Camera: Natus RetCam Envision (130° FOV). Pediatric retinal photograph (wide-field): 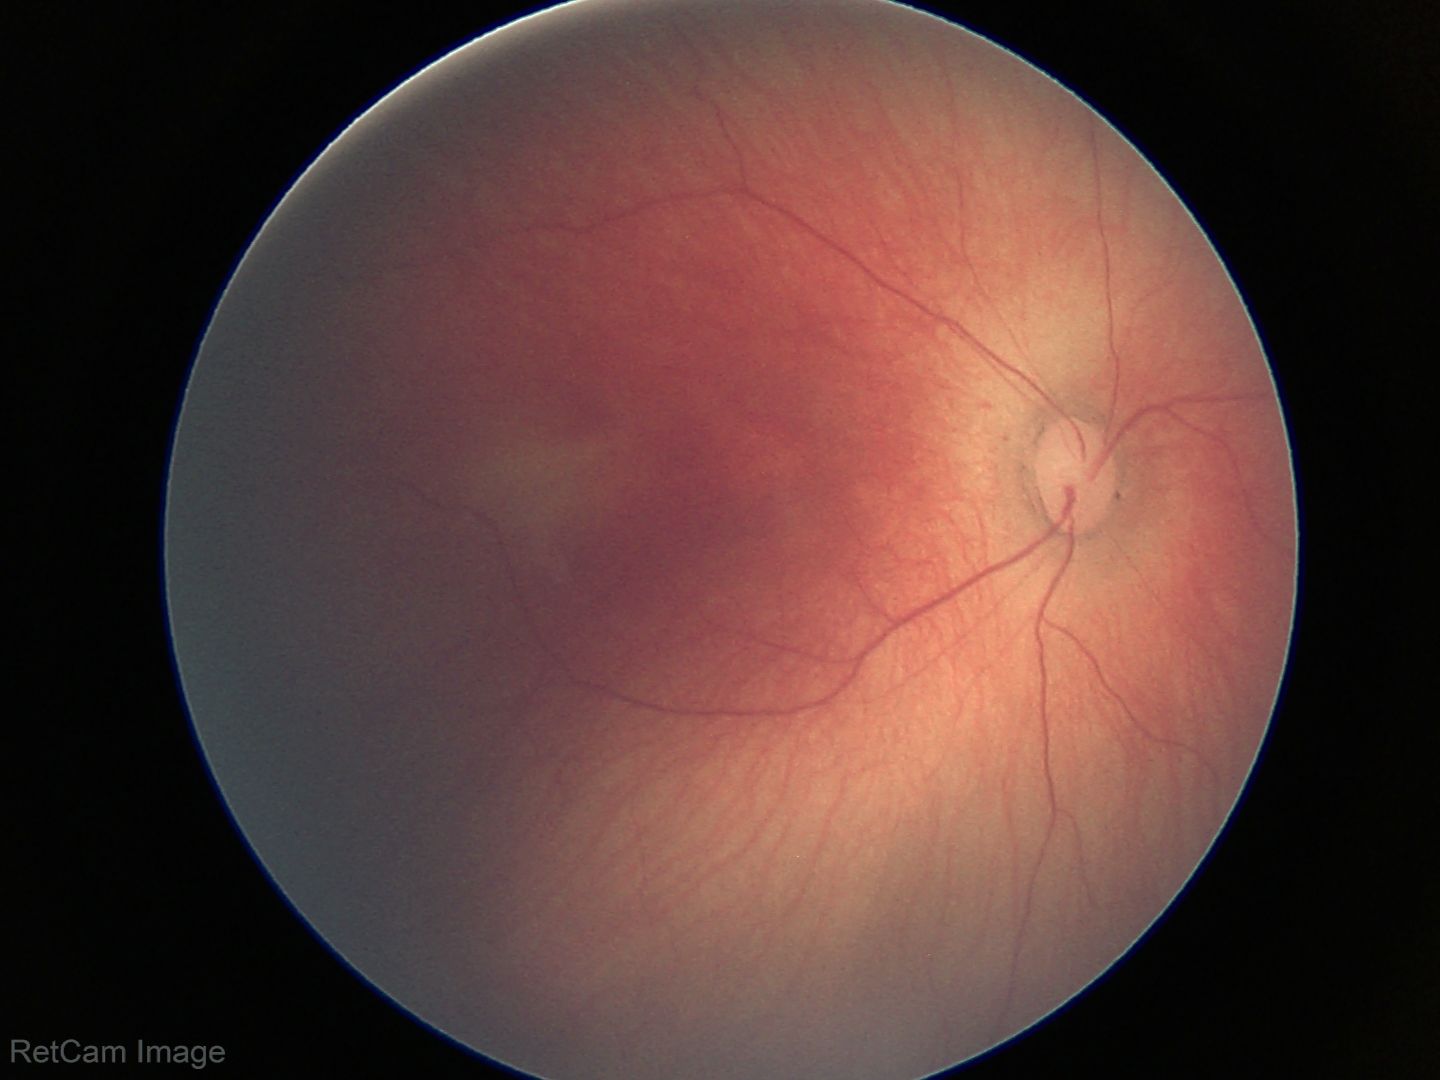

Screening: no plus disease | retinopathy of prematurity stage 1.